Color fundus image; image size 2352x1568
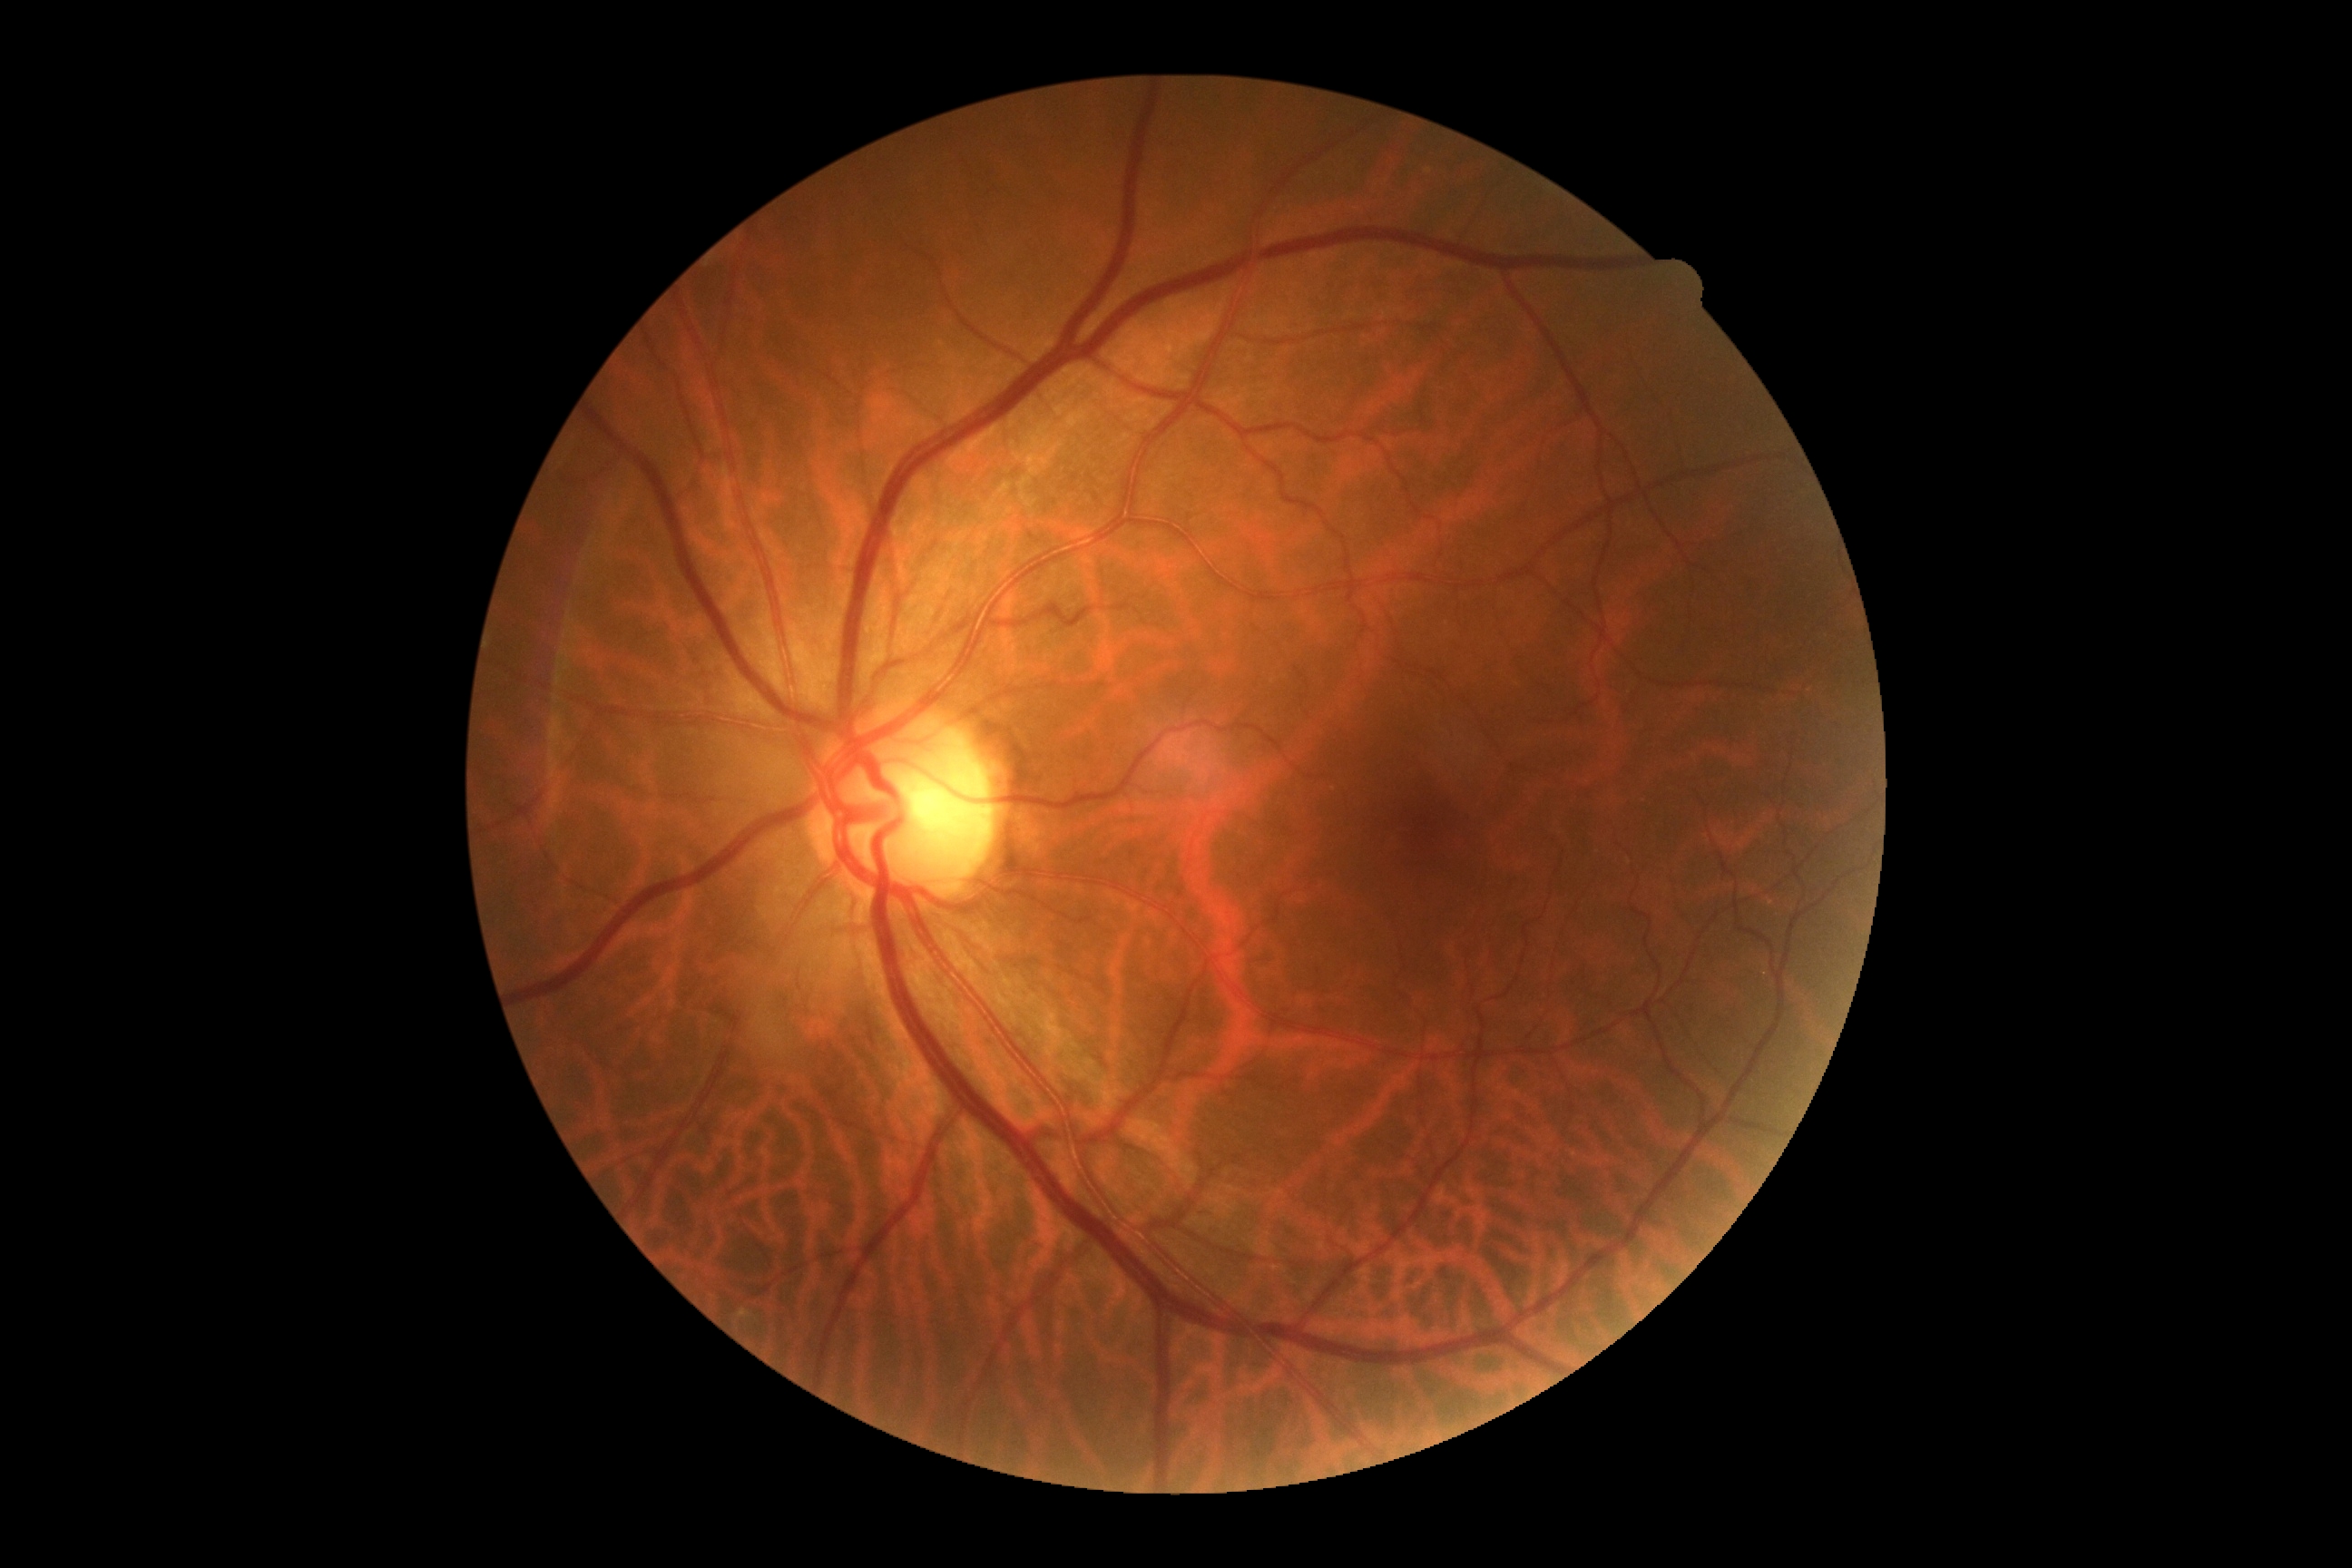 Diabetic retinopathy (DR): grade 0 (no apparent retinopathy) — no visible signs of diabetic retinopathy.